Modified Davis grading. Without pupil dilation — 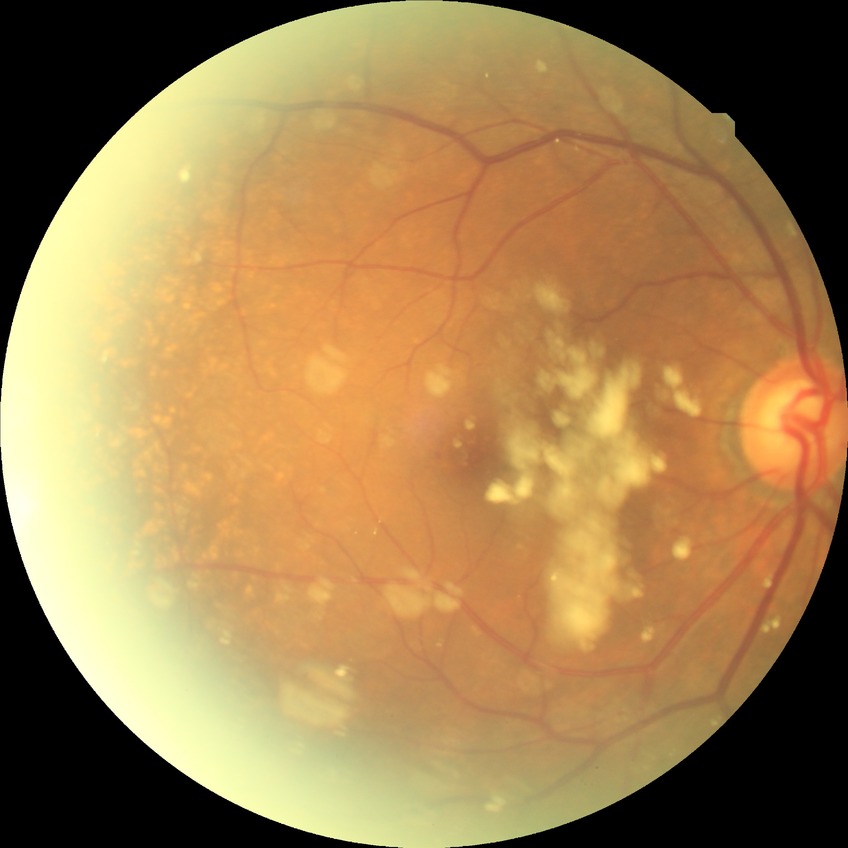
Findings:
• diabetic retinopathy (DR) — no diabetic retinopathy (NDR)